Color fundus photograph. 2352x1568. 45-degree field of view: 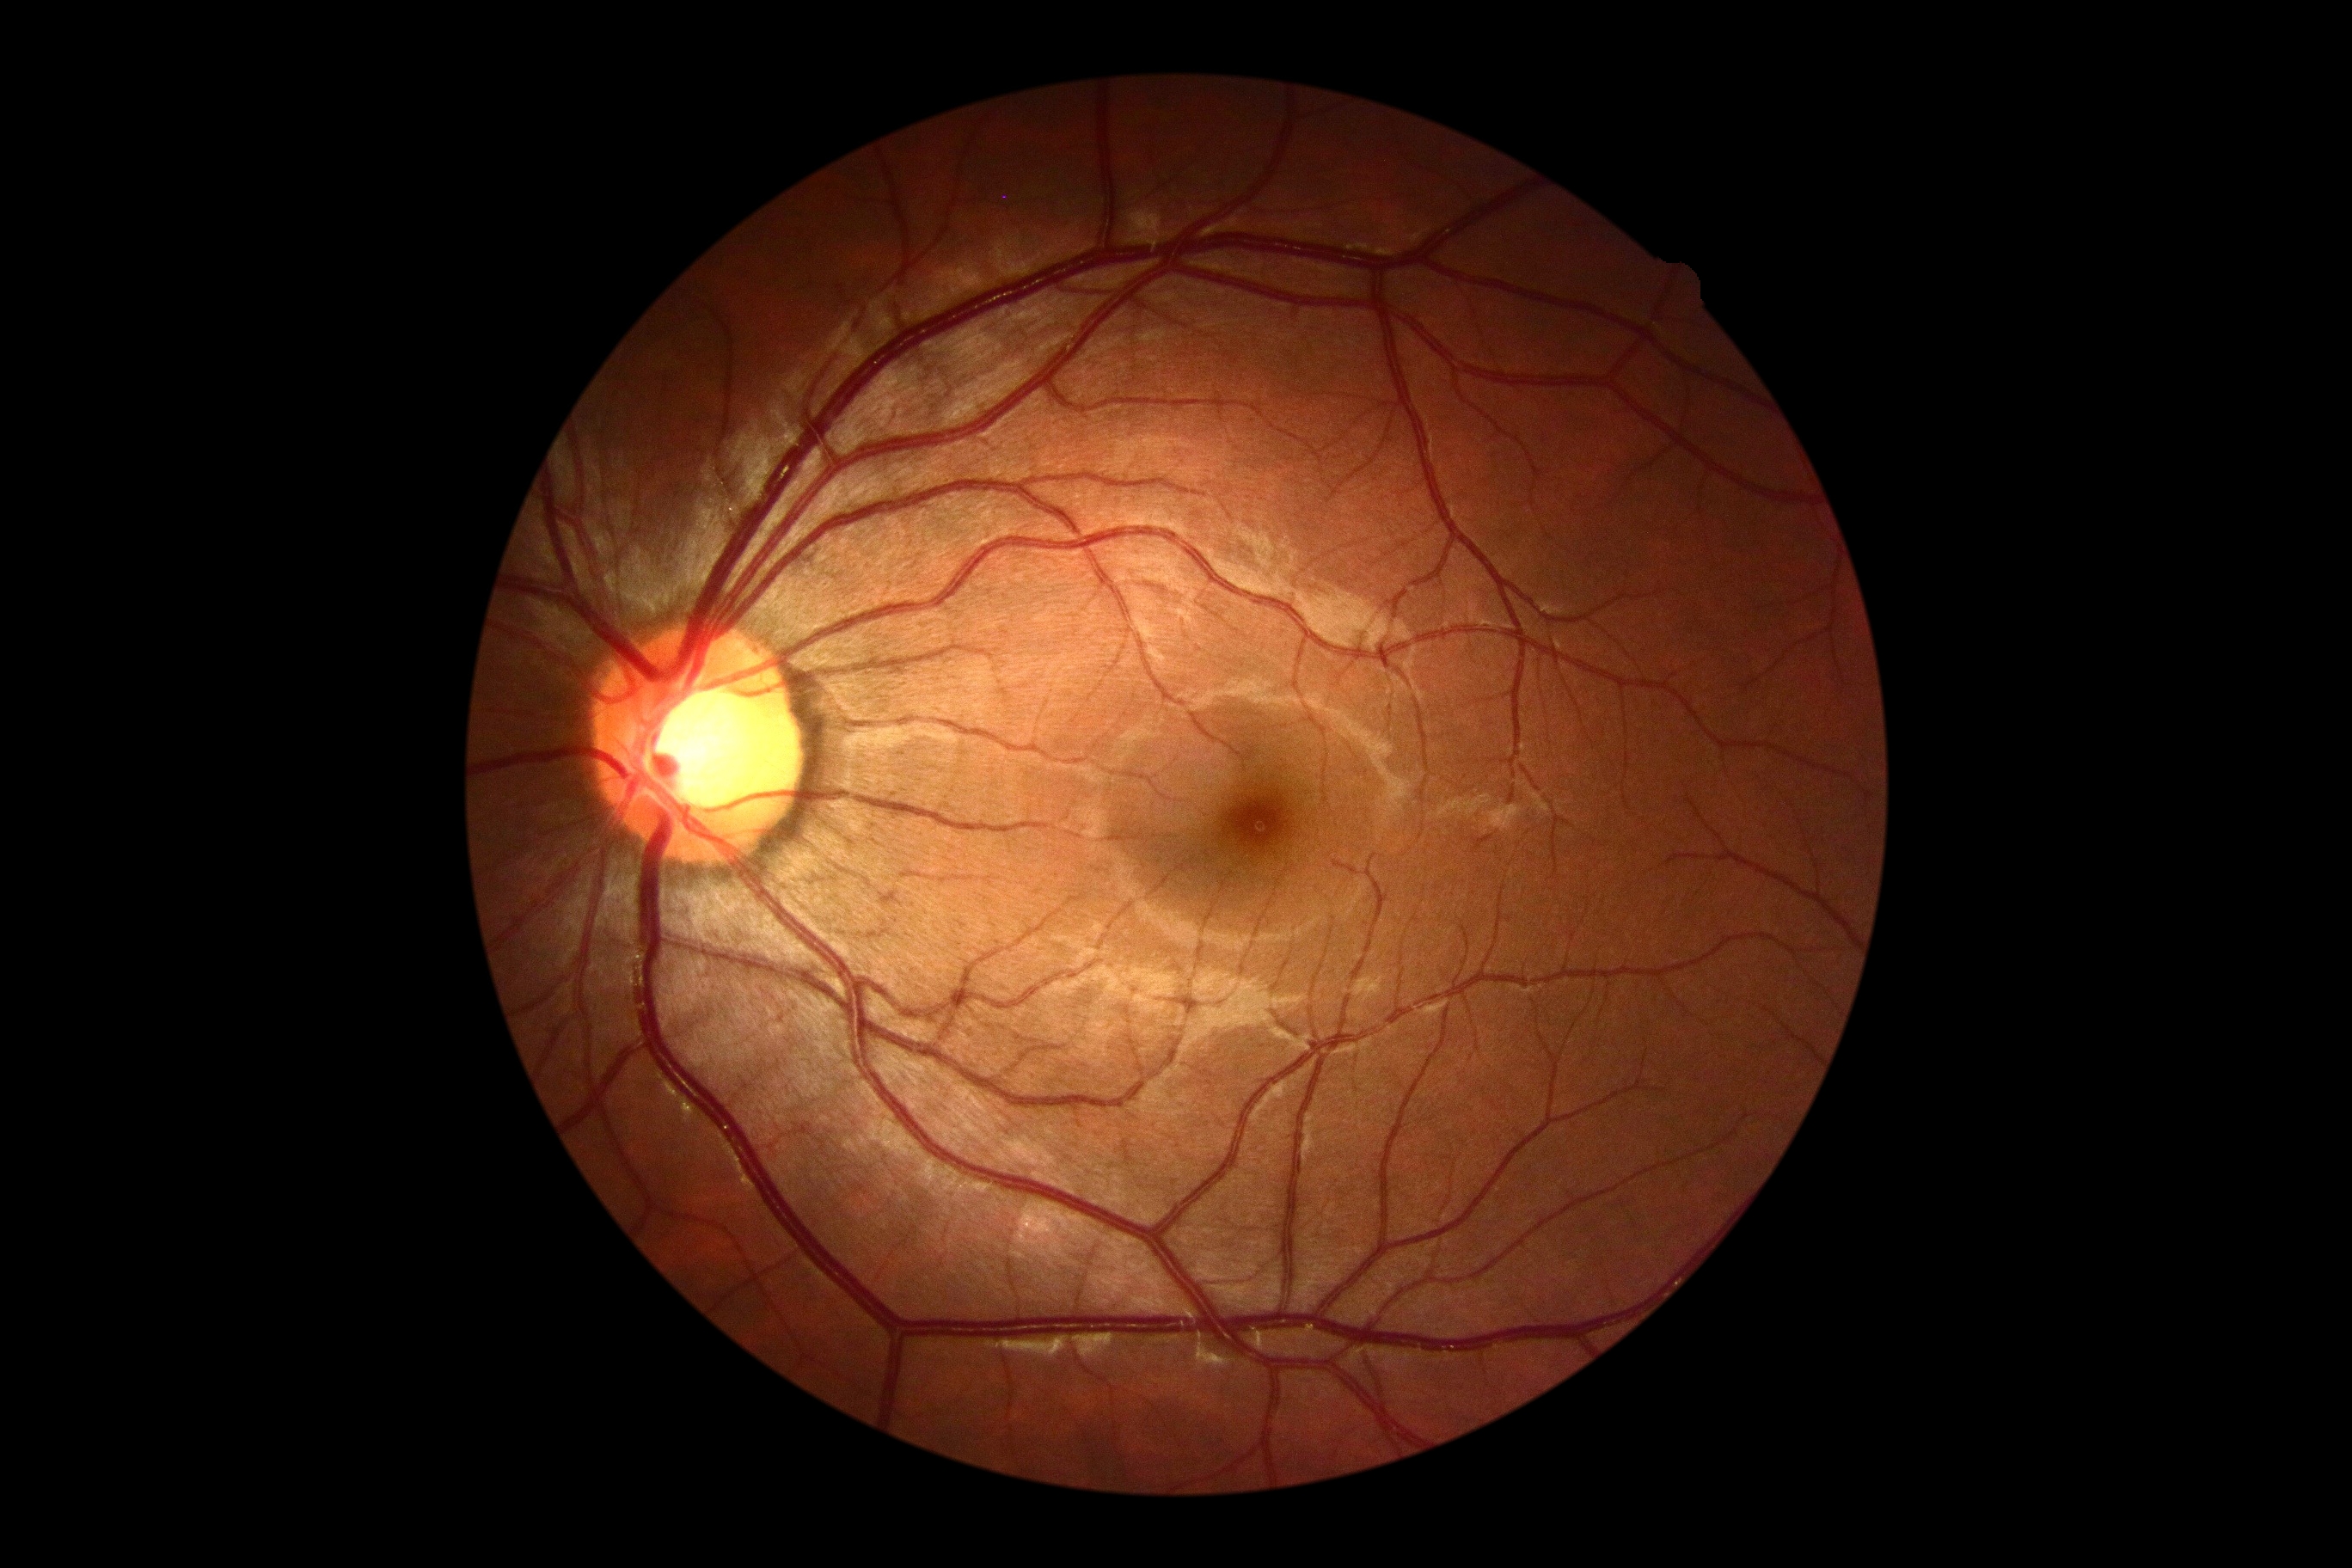

DR severity is 0.